Color fundus image.
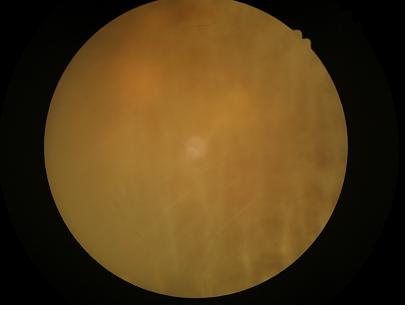 Poor dynamic range. Out of focus; structures are indistinct. Illumination and color are suboptimal. Image quality is inadequate for diagnostic use.